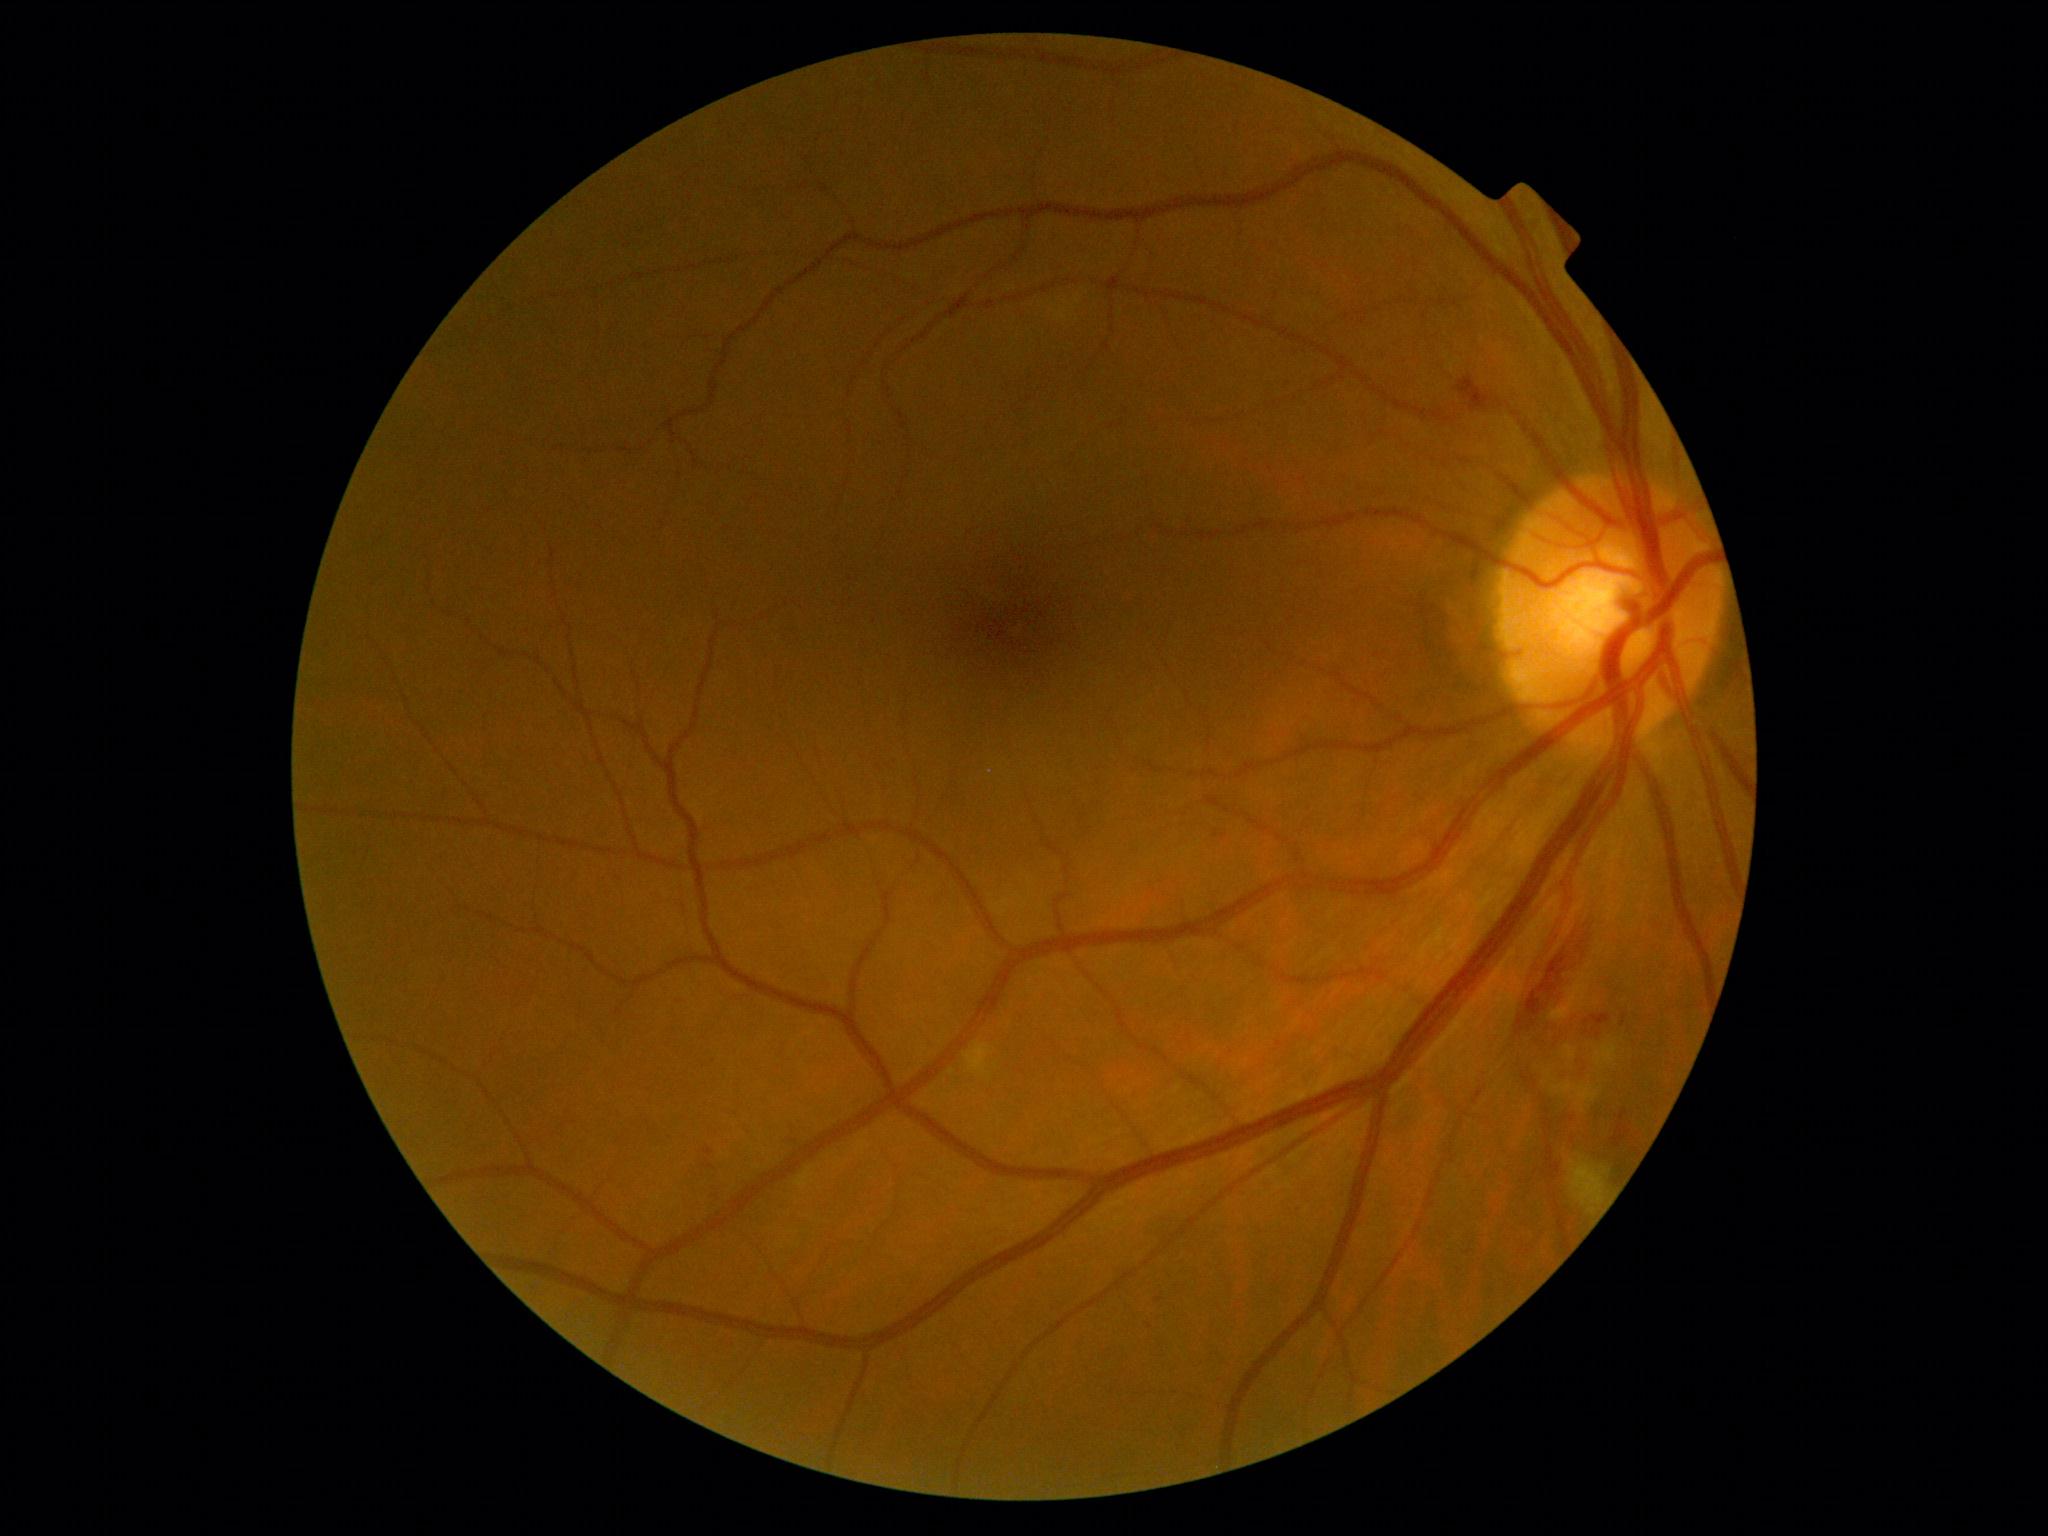
Findings:
- DR class: non-proliferative diabetic retinopathy
- diabetic retinopathy grade: 2